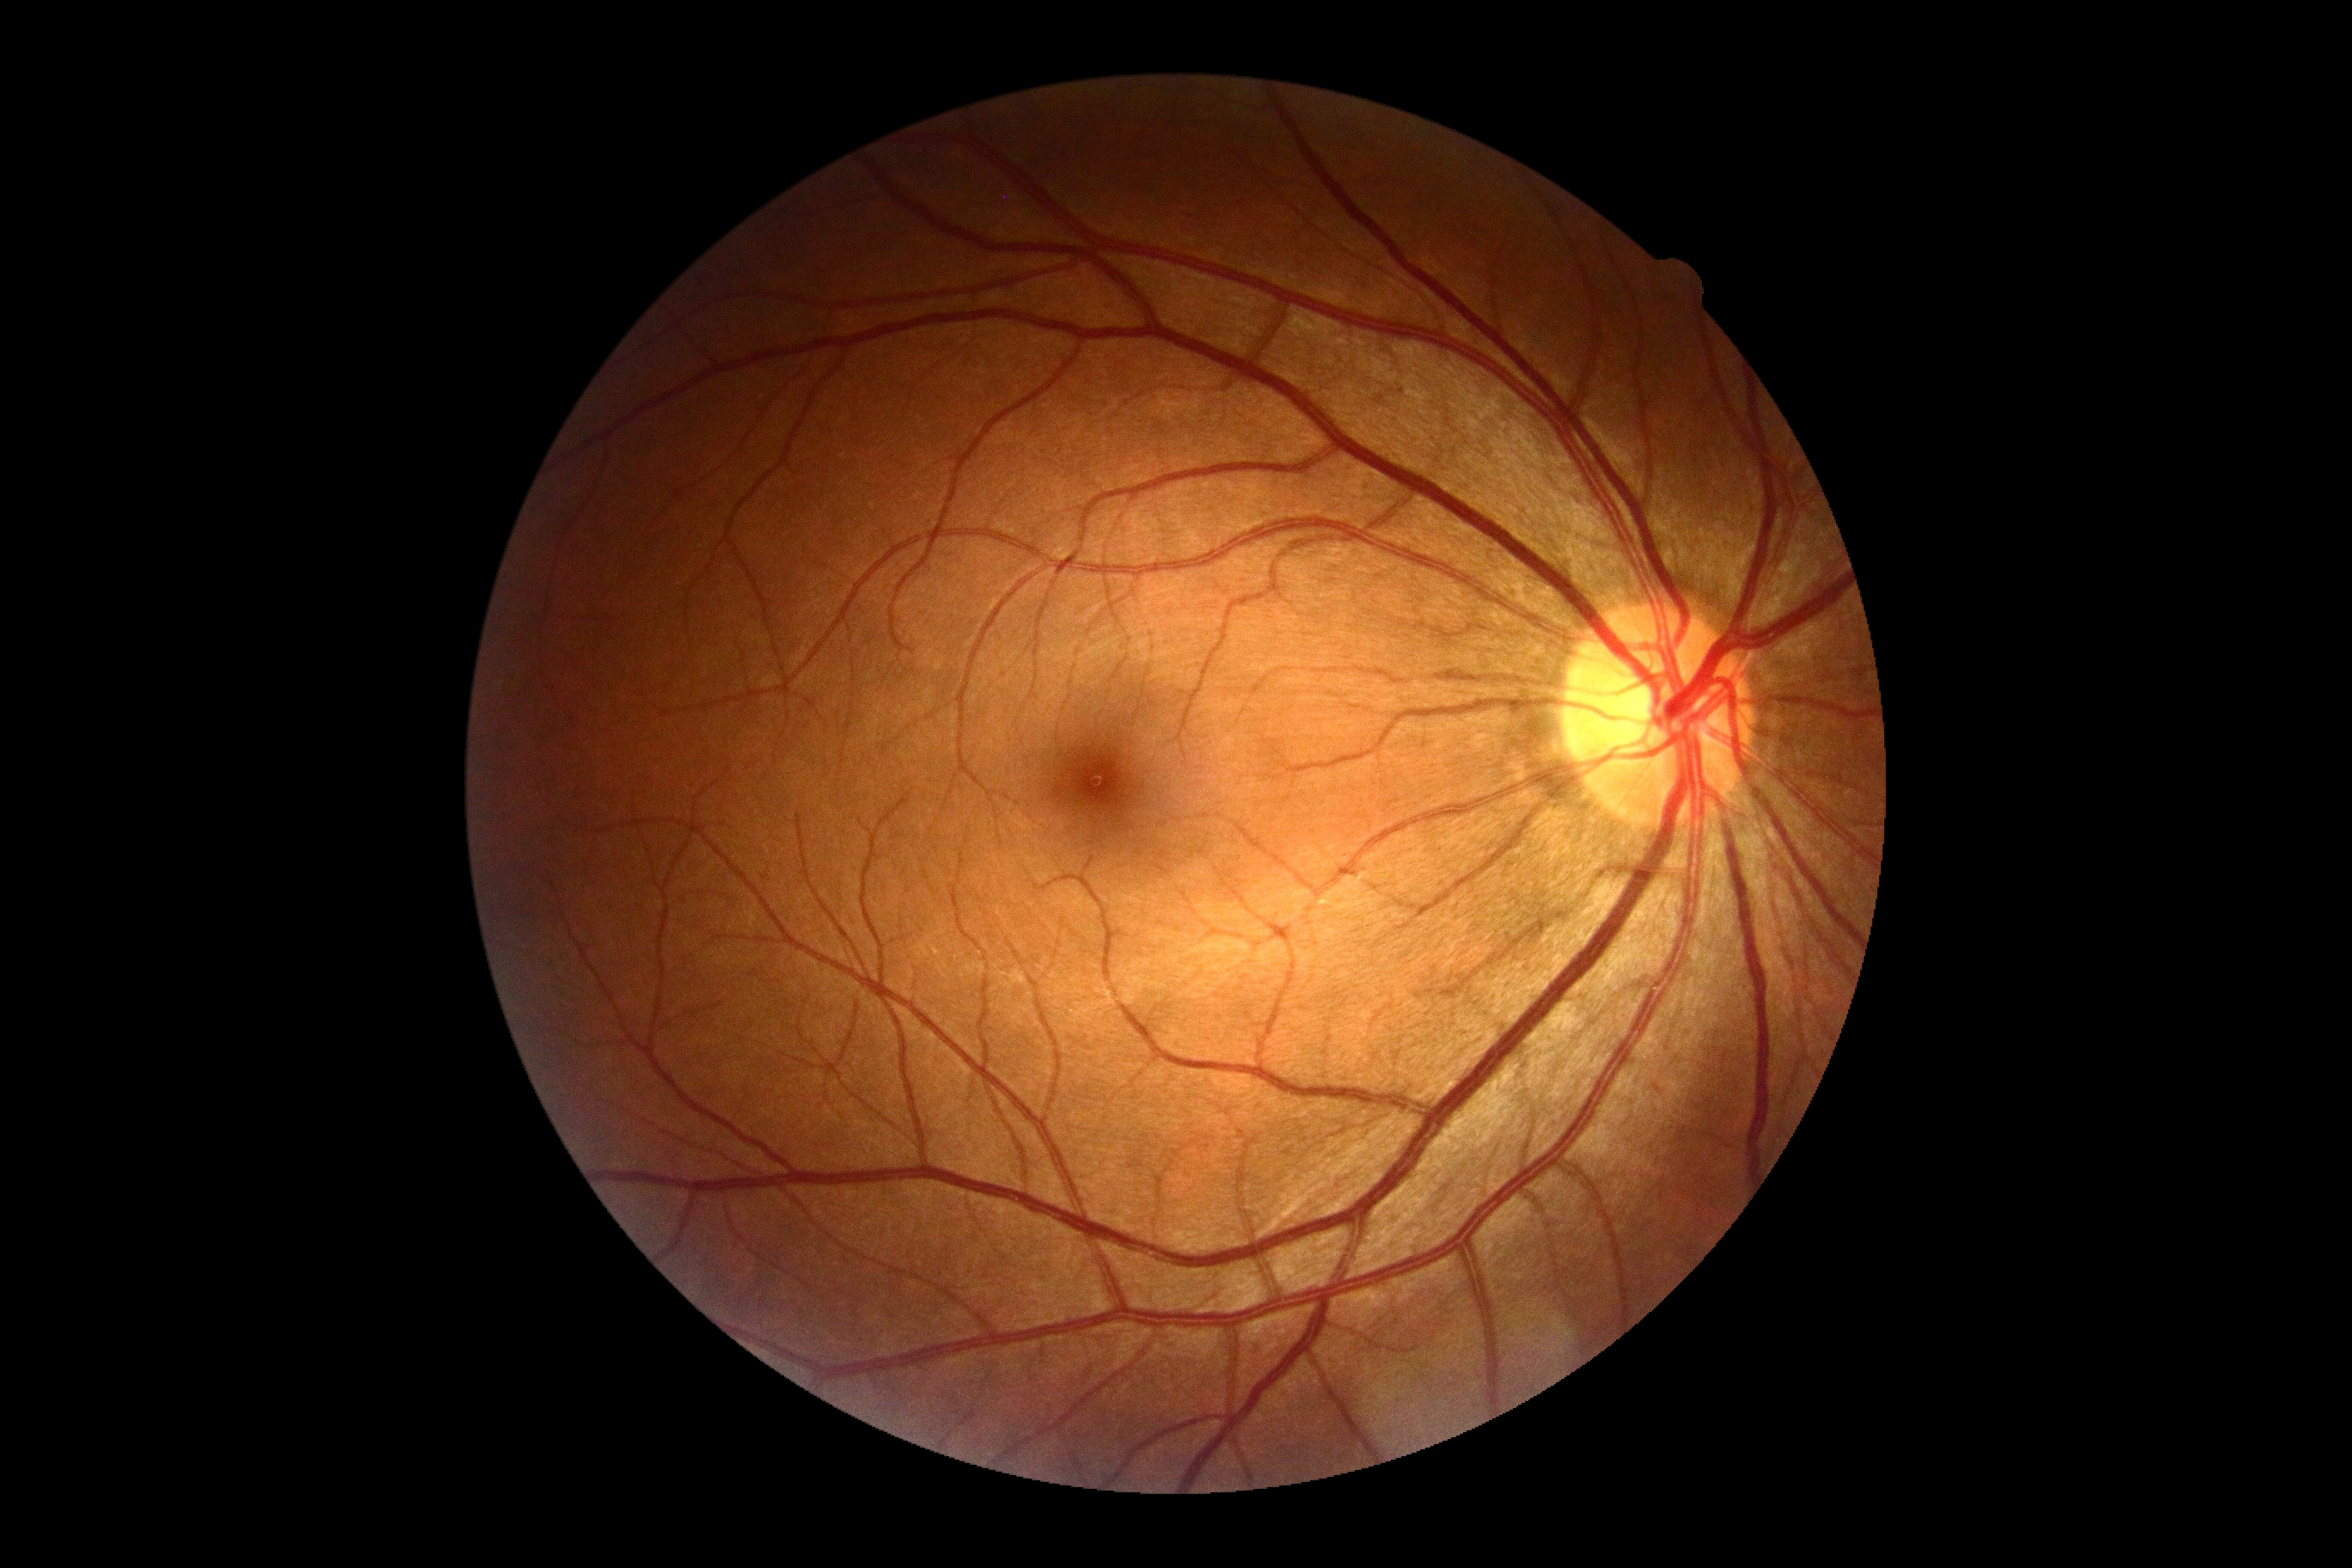

DR impression: no signs of DR; diabetic retinopathy grade: 0 (no apparent retinopathy).